CFP.
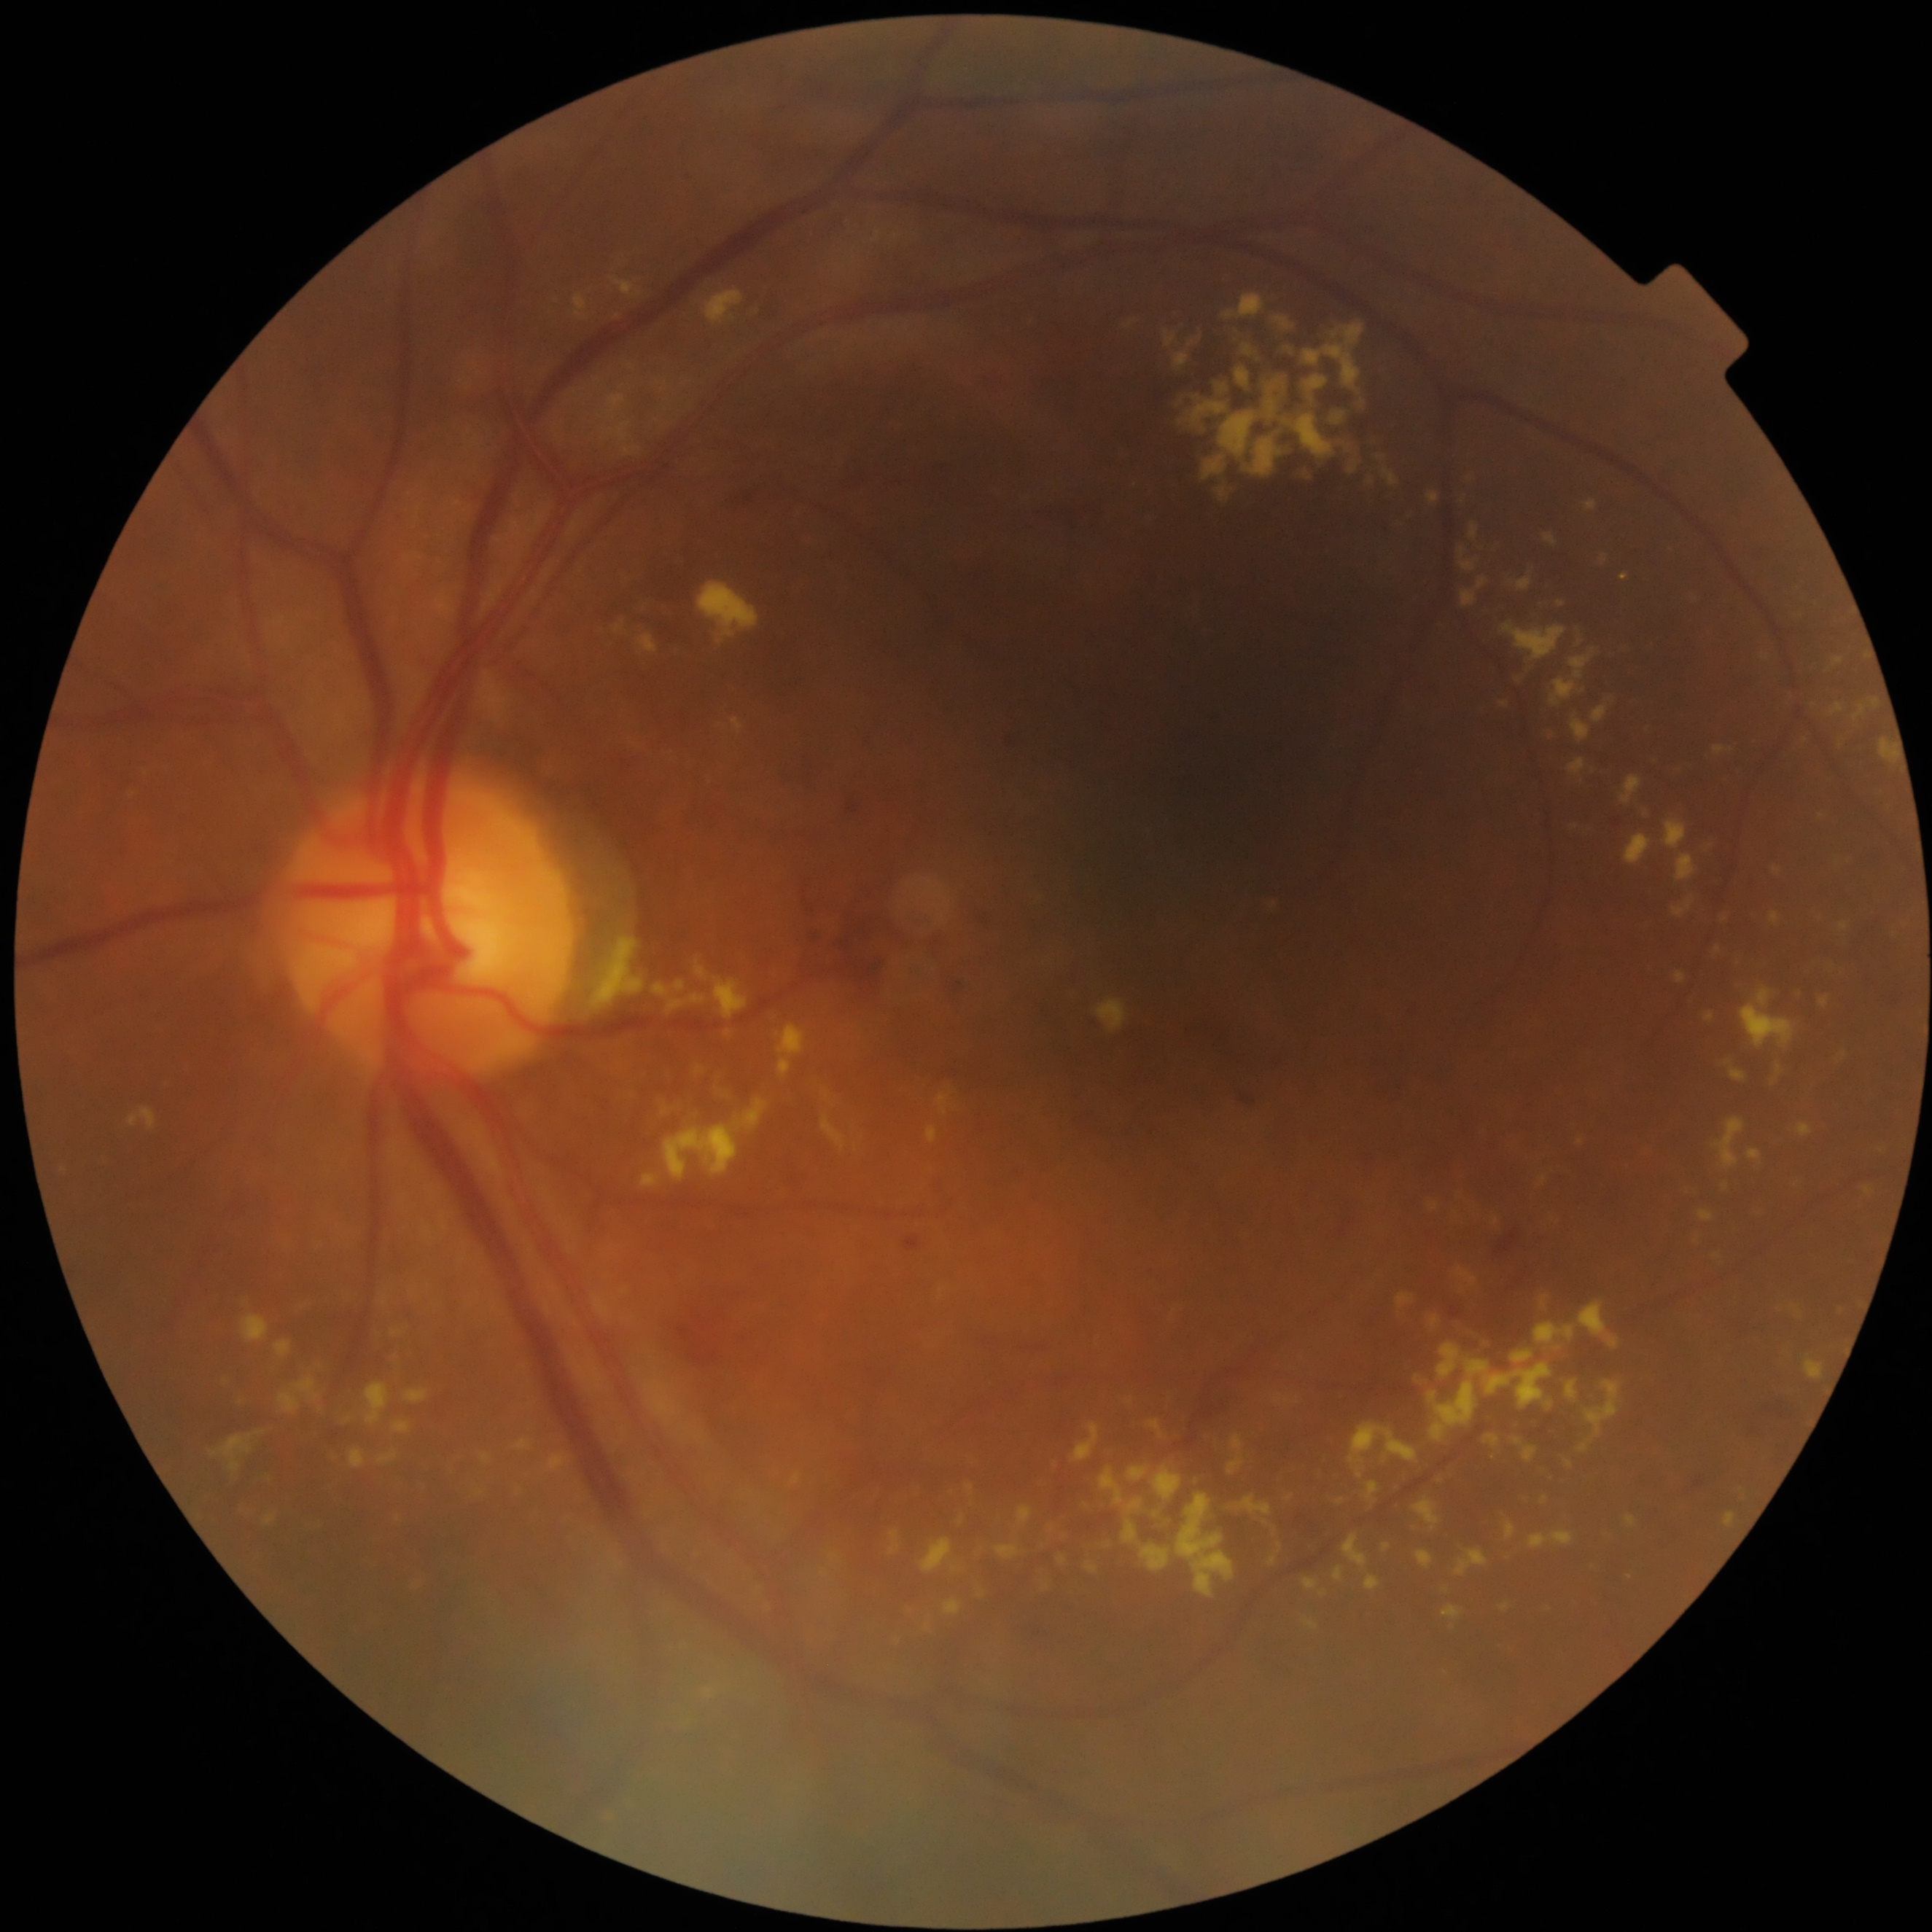
Diabetic retinopathy (DR) is grade 2. The retinopathy is classified as non-proliferative diabetic retinopathy.